NIDEK AFC-230 fundus camera: 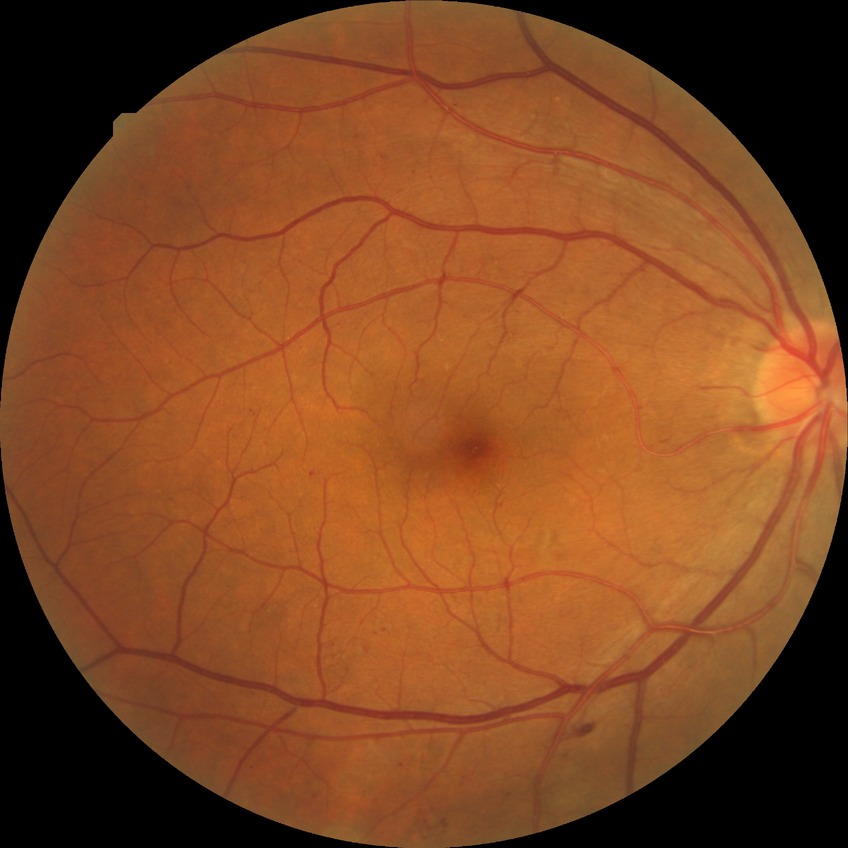
Assessment:
• diabetic retinopathy (DR): PPDR (pre-proliferative diabetic retinopathy)